Camera: NIDEK AFC-230 · Davis DR grading · FOV: 45 degrees — 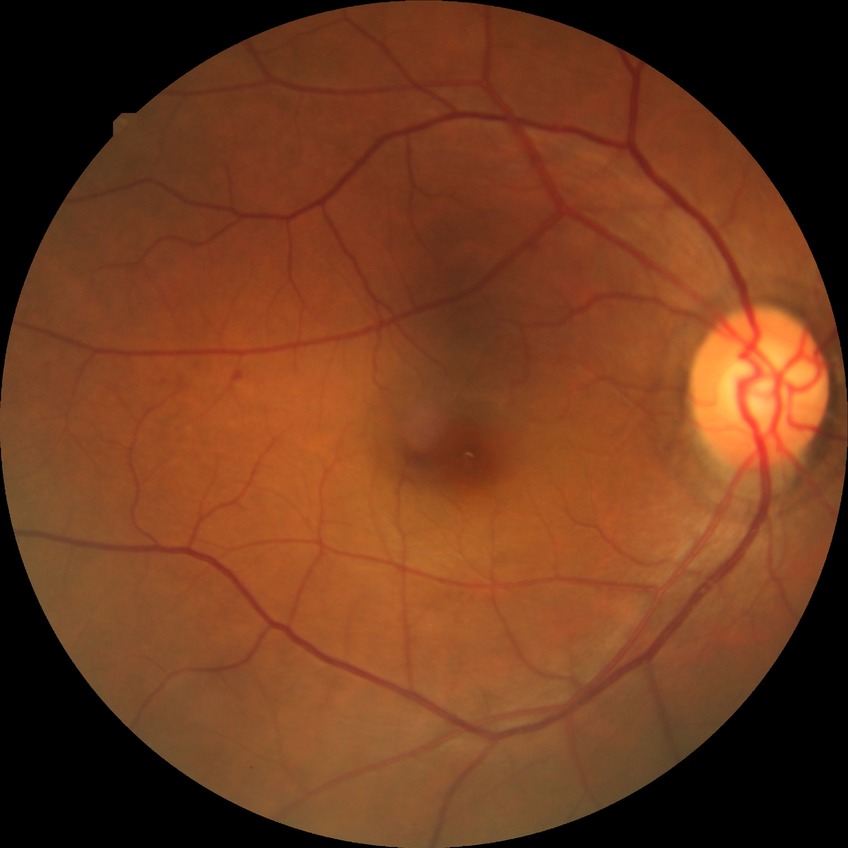 Diabetic retinopathy (DR) is simple diabetic retinopathy (SDR).